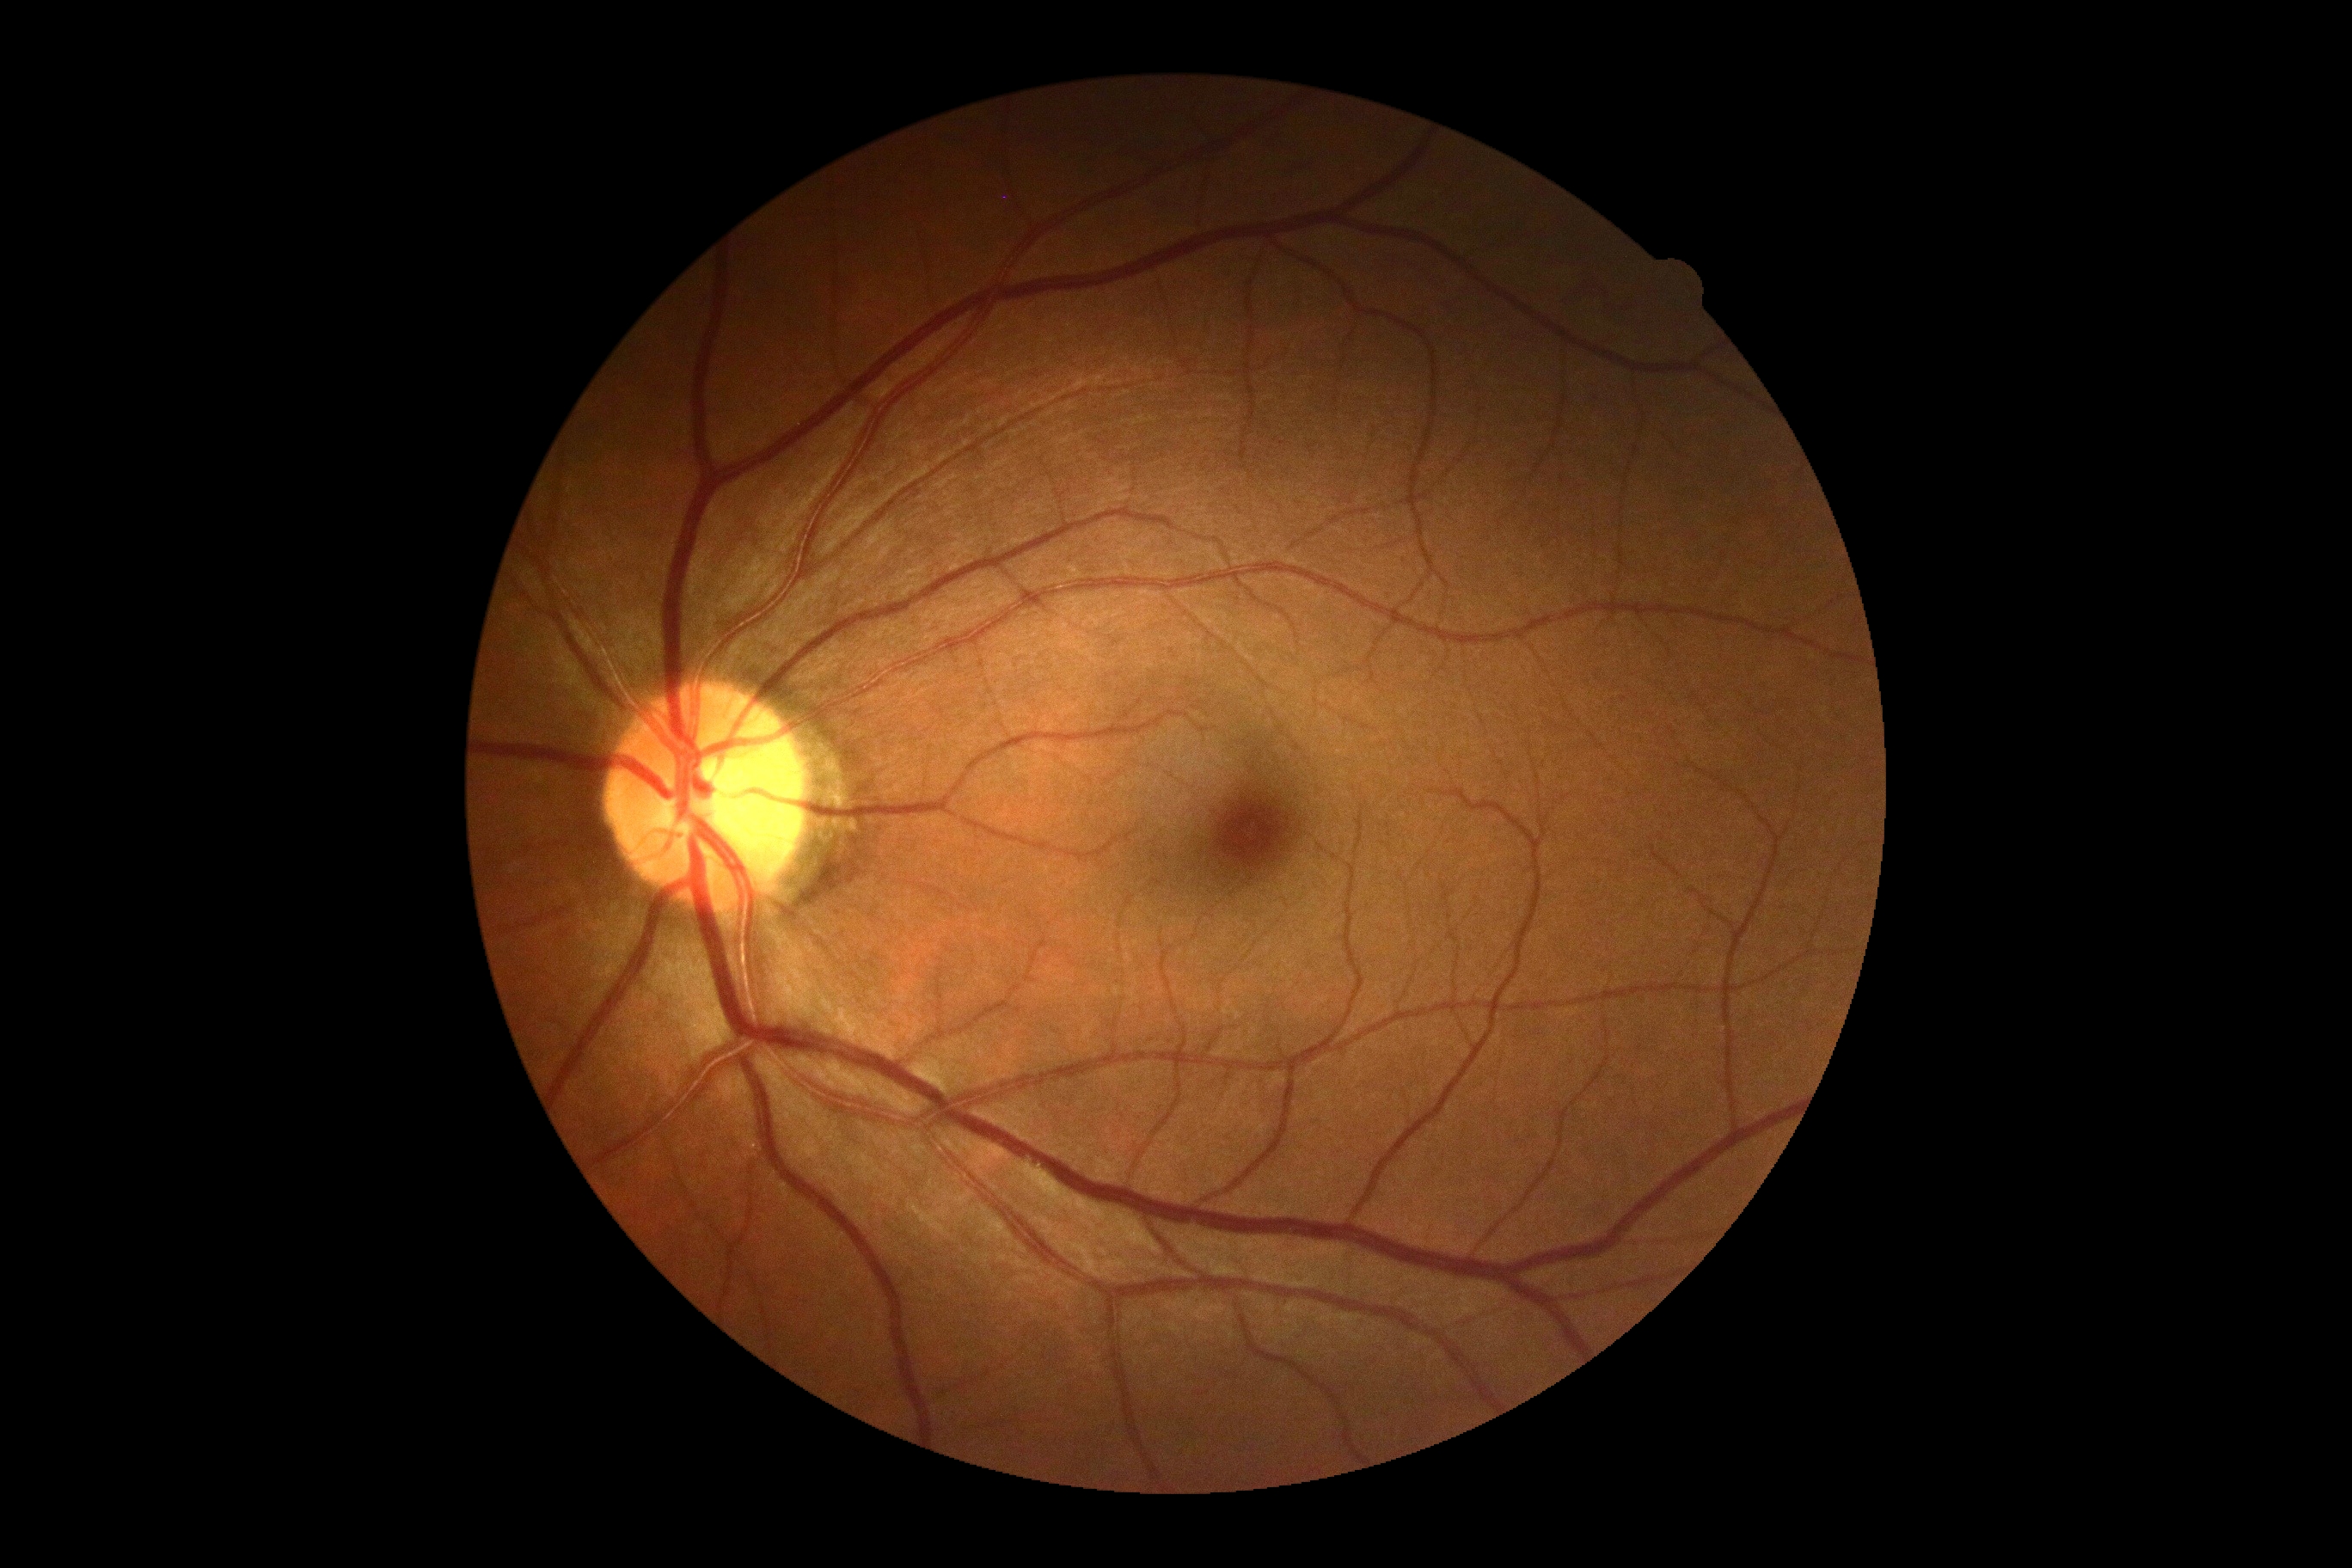
DR is no apparent diabetic retinopathy (grade 0).